848x848px — 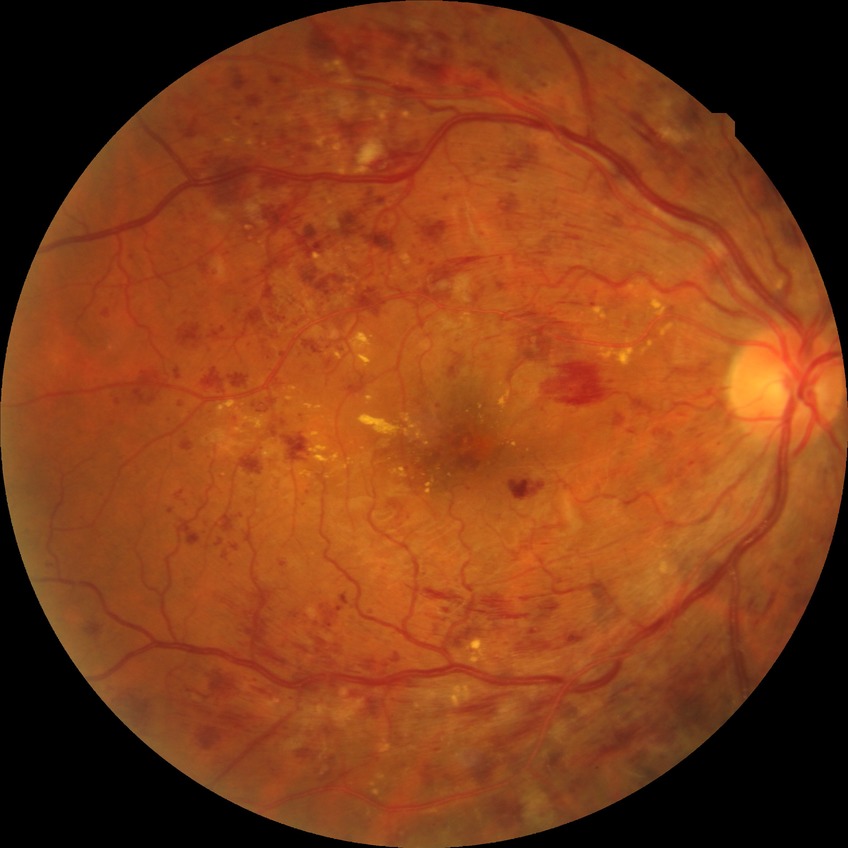

Davis grade is PPDR.